Wide-field contact fundus photograph of an infant. Camera: Phoenix ICON (100° FOV): 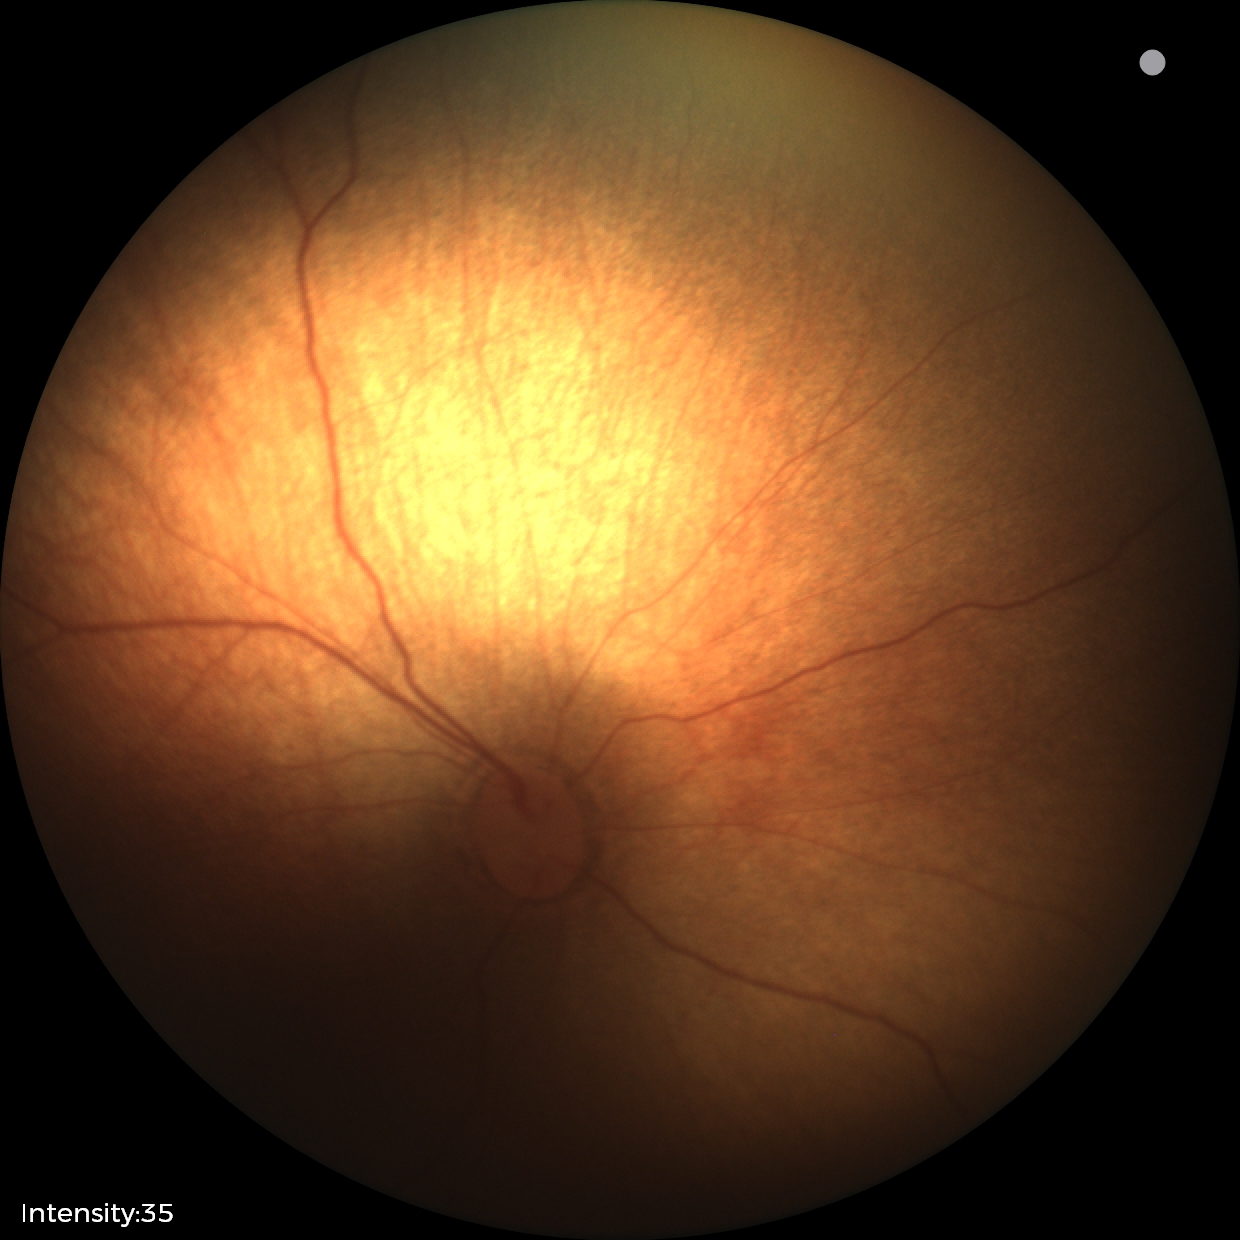 Physiological retinal appearance for postconceptual age.